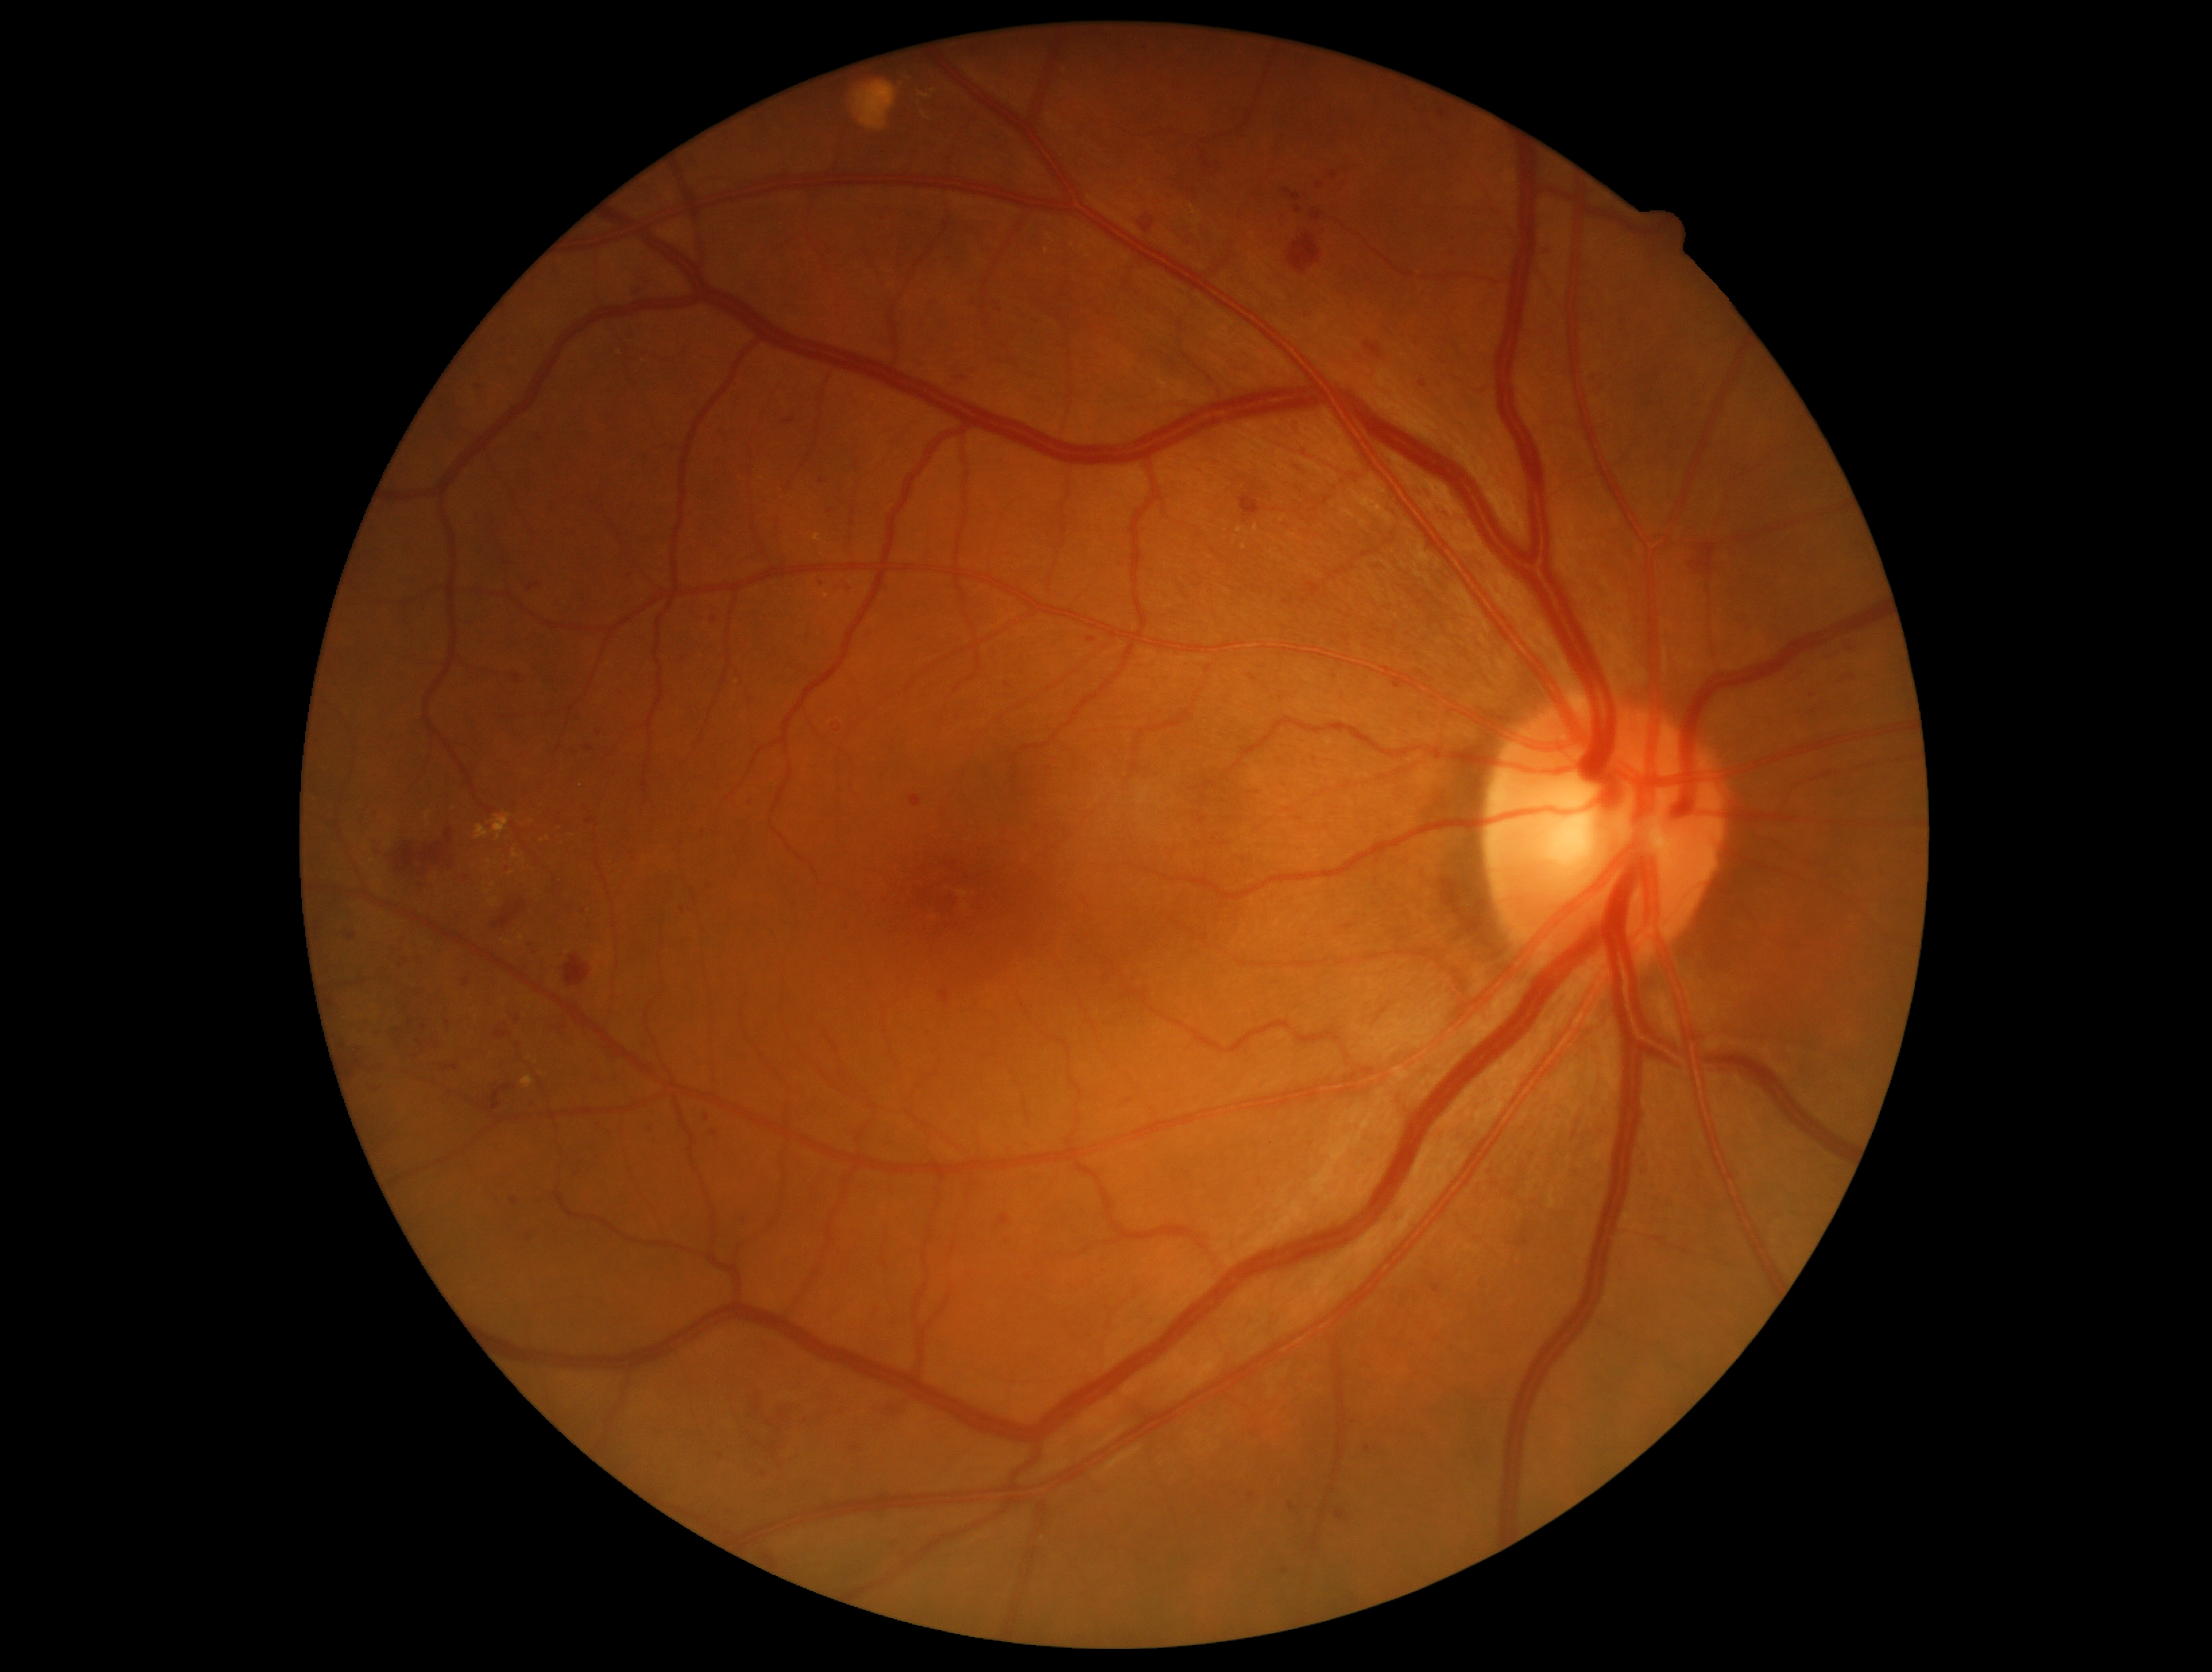

DR: 2/4. DR class: non-proliferative diabetic retinopathy.